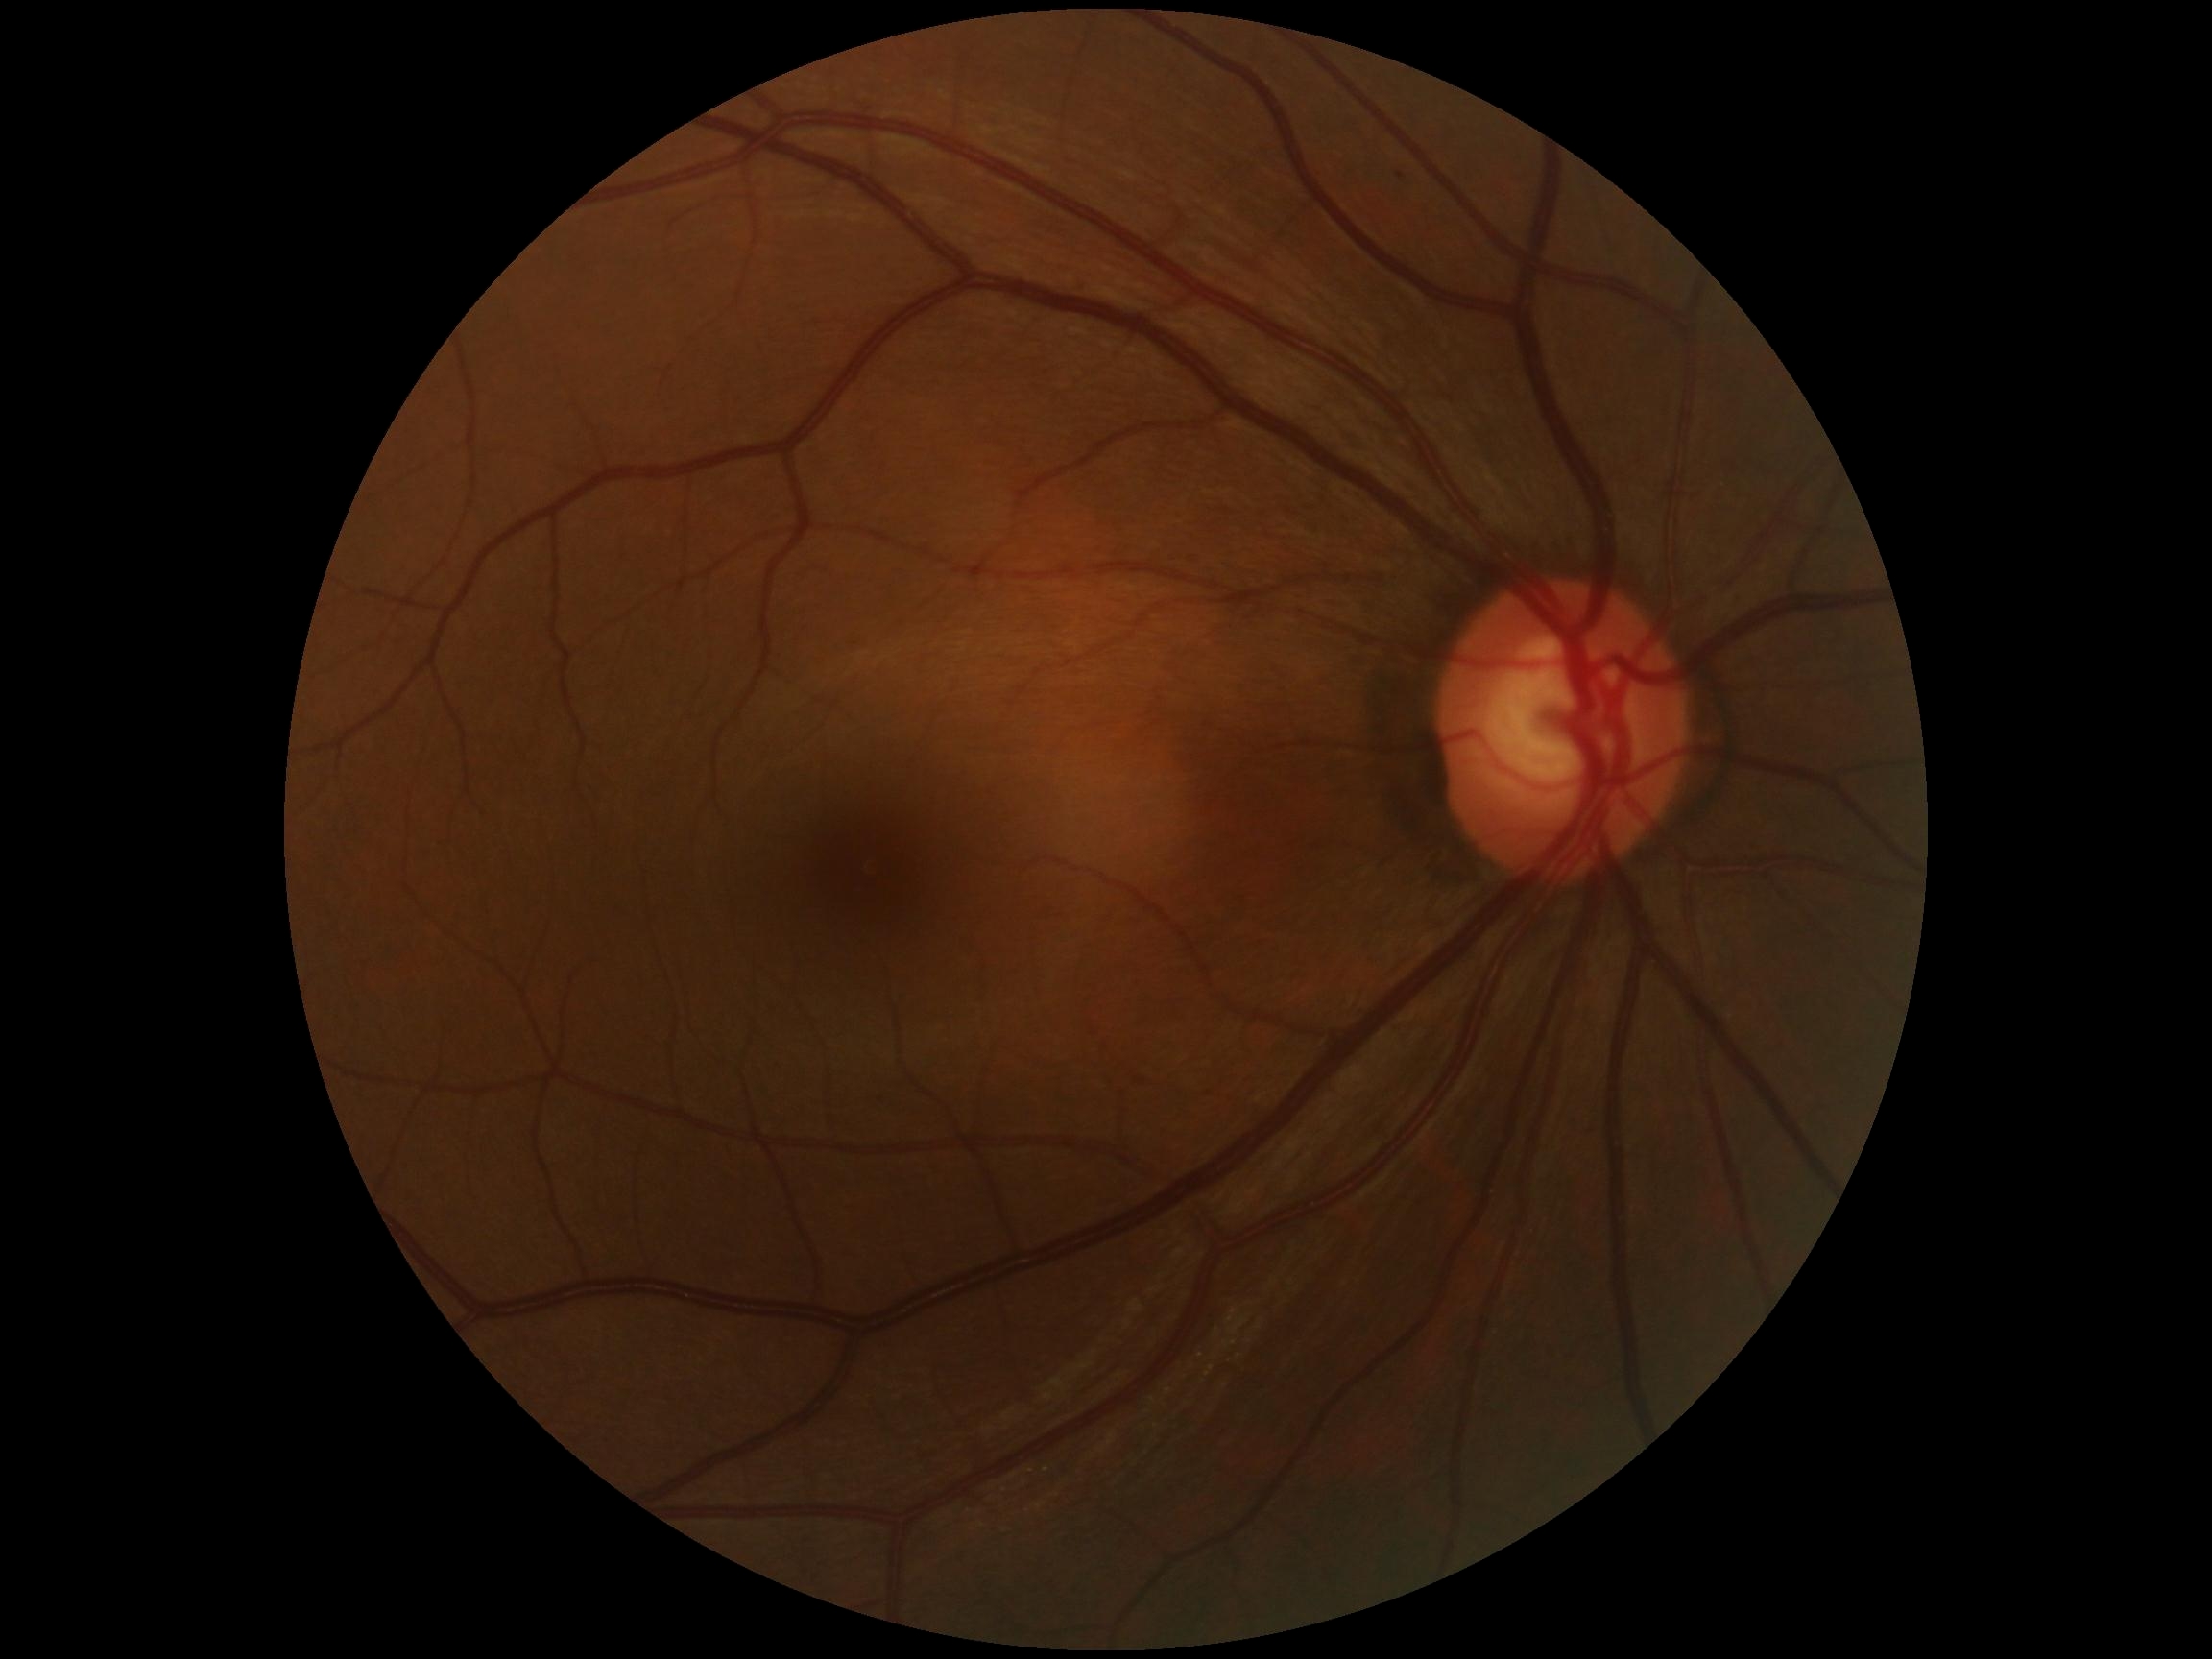
Diabetic retinopathy grade: 0.